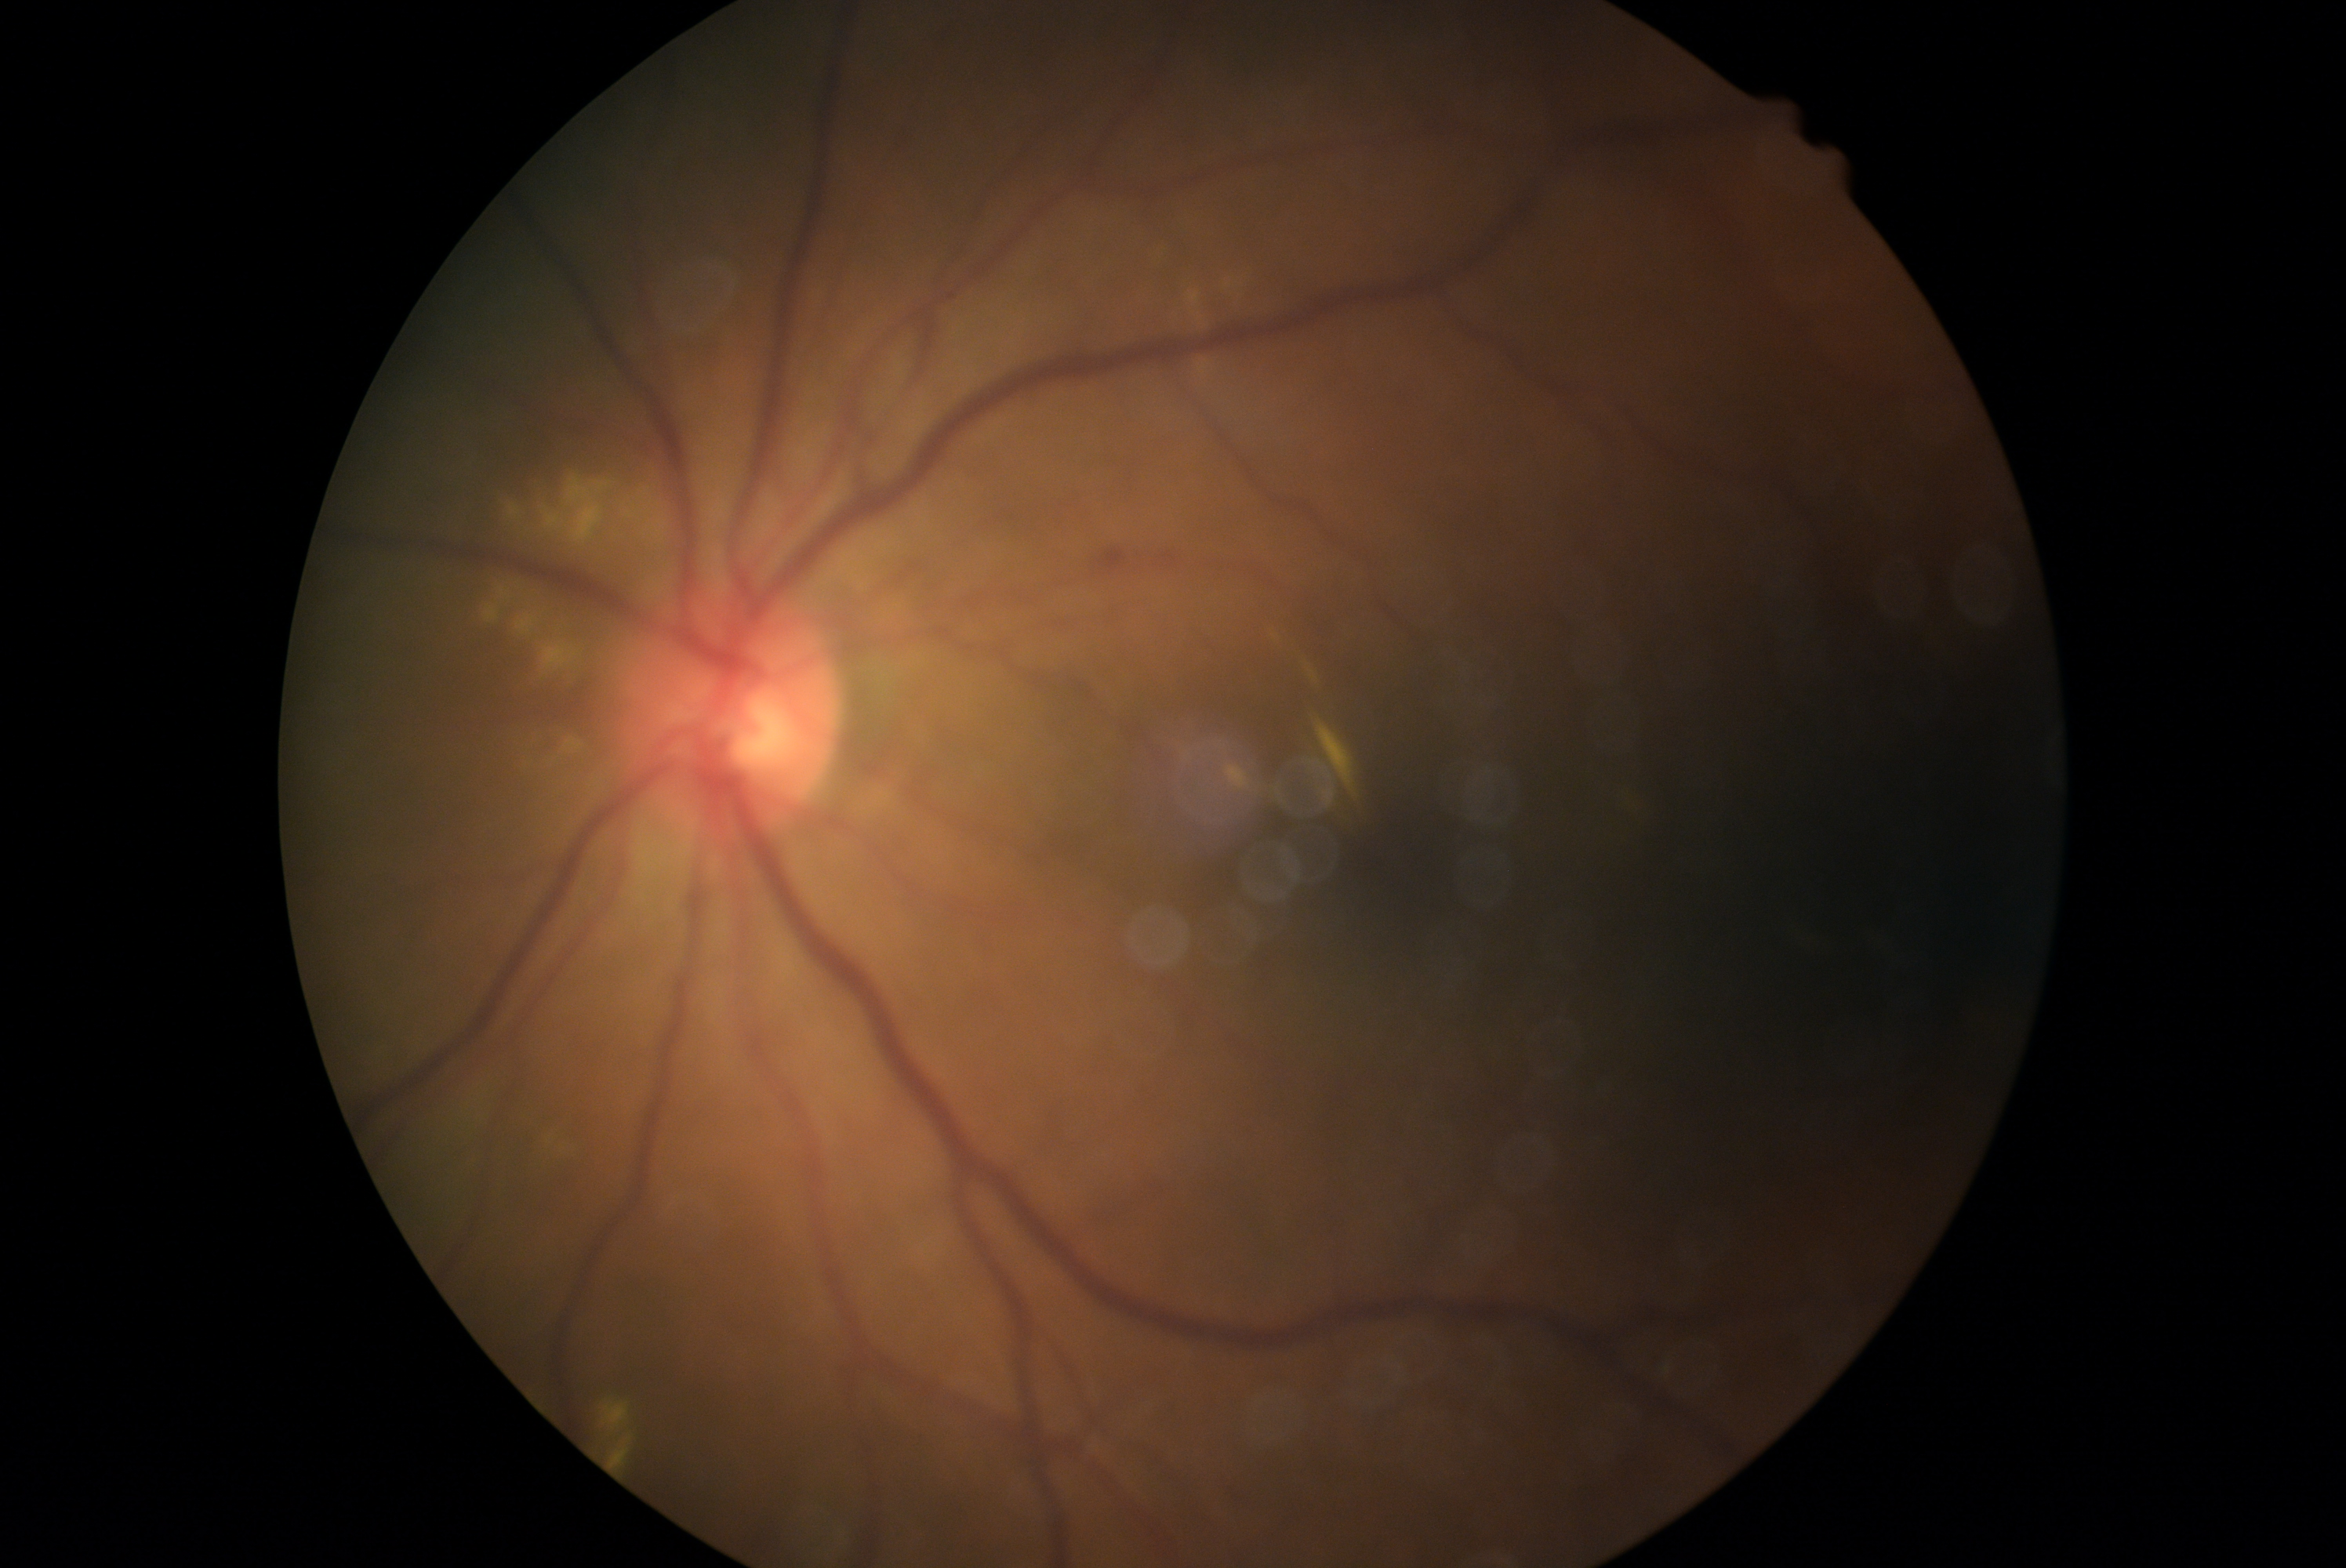
DR grade = 2 (moderate NPDR).